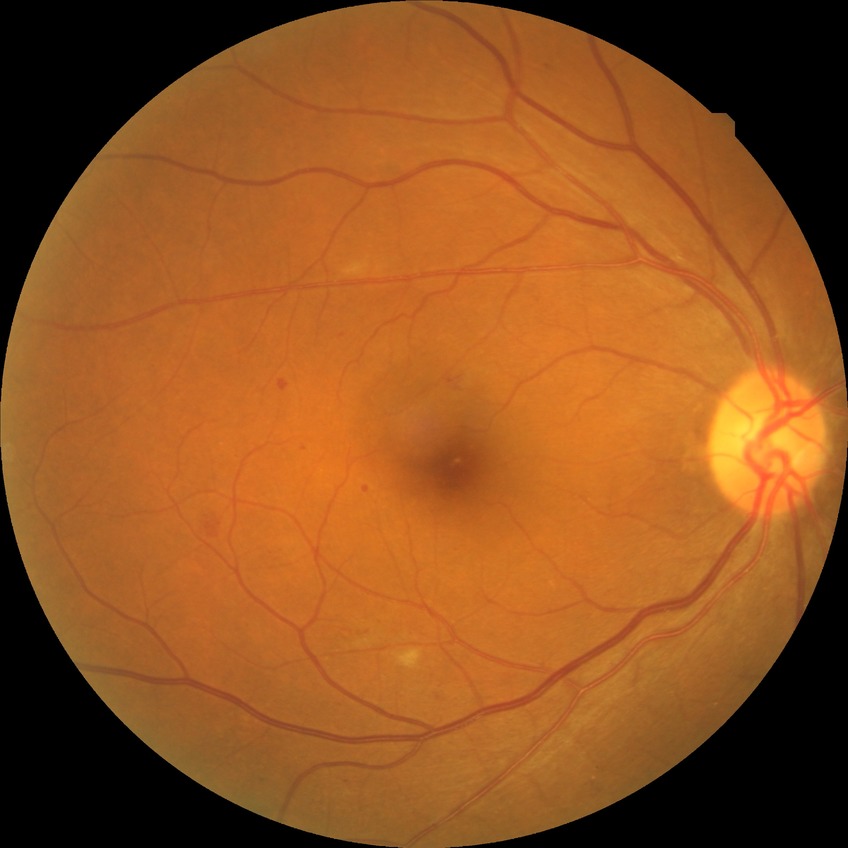 DR class: non-proliferative diabetic retinopathy.
DR severity: PPDR.